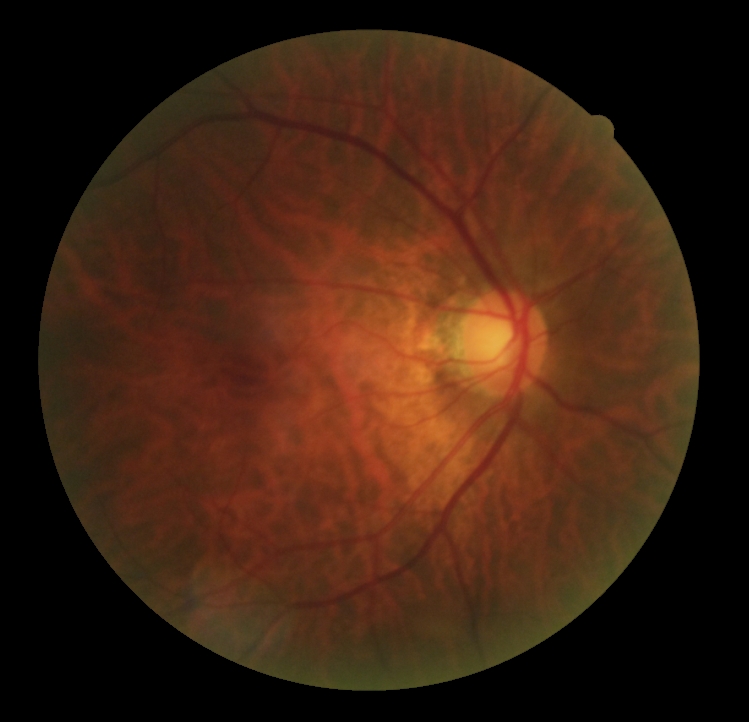 Retinopathy is 0/4.